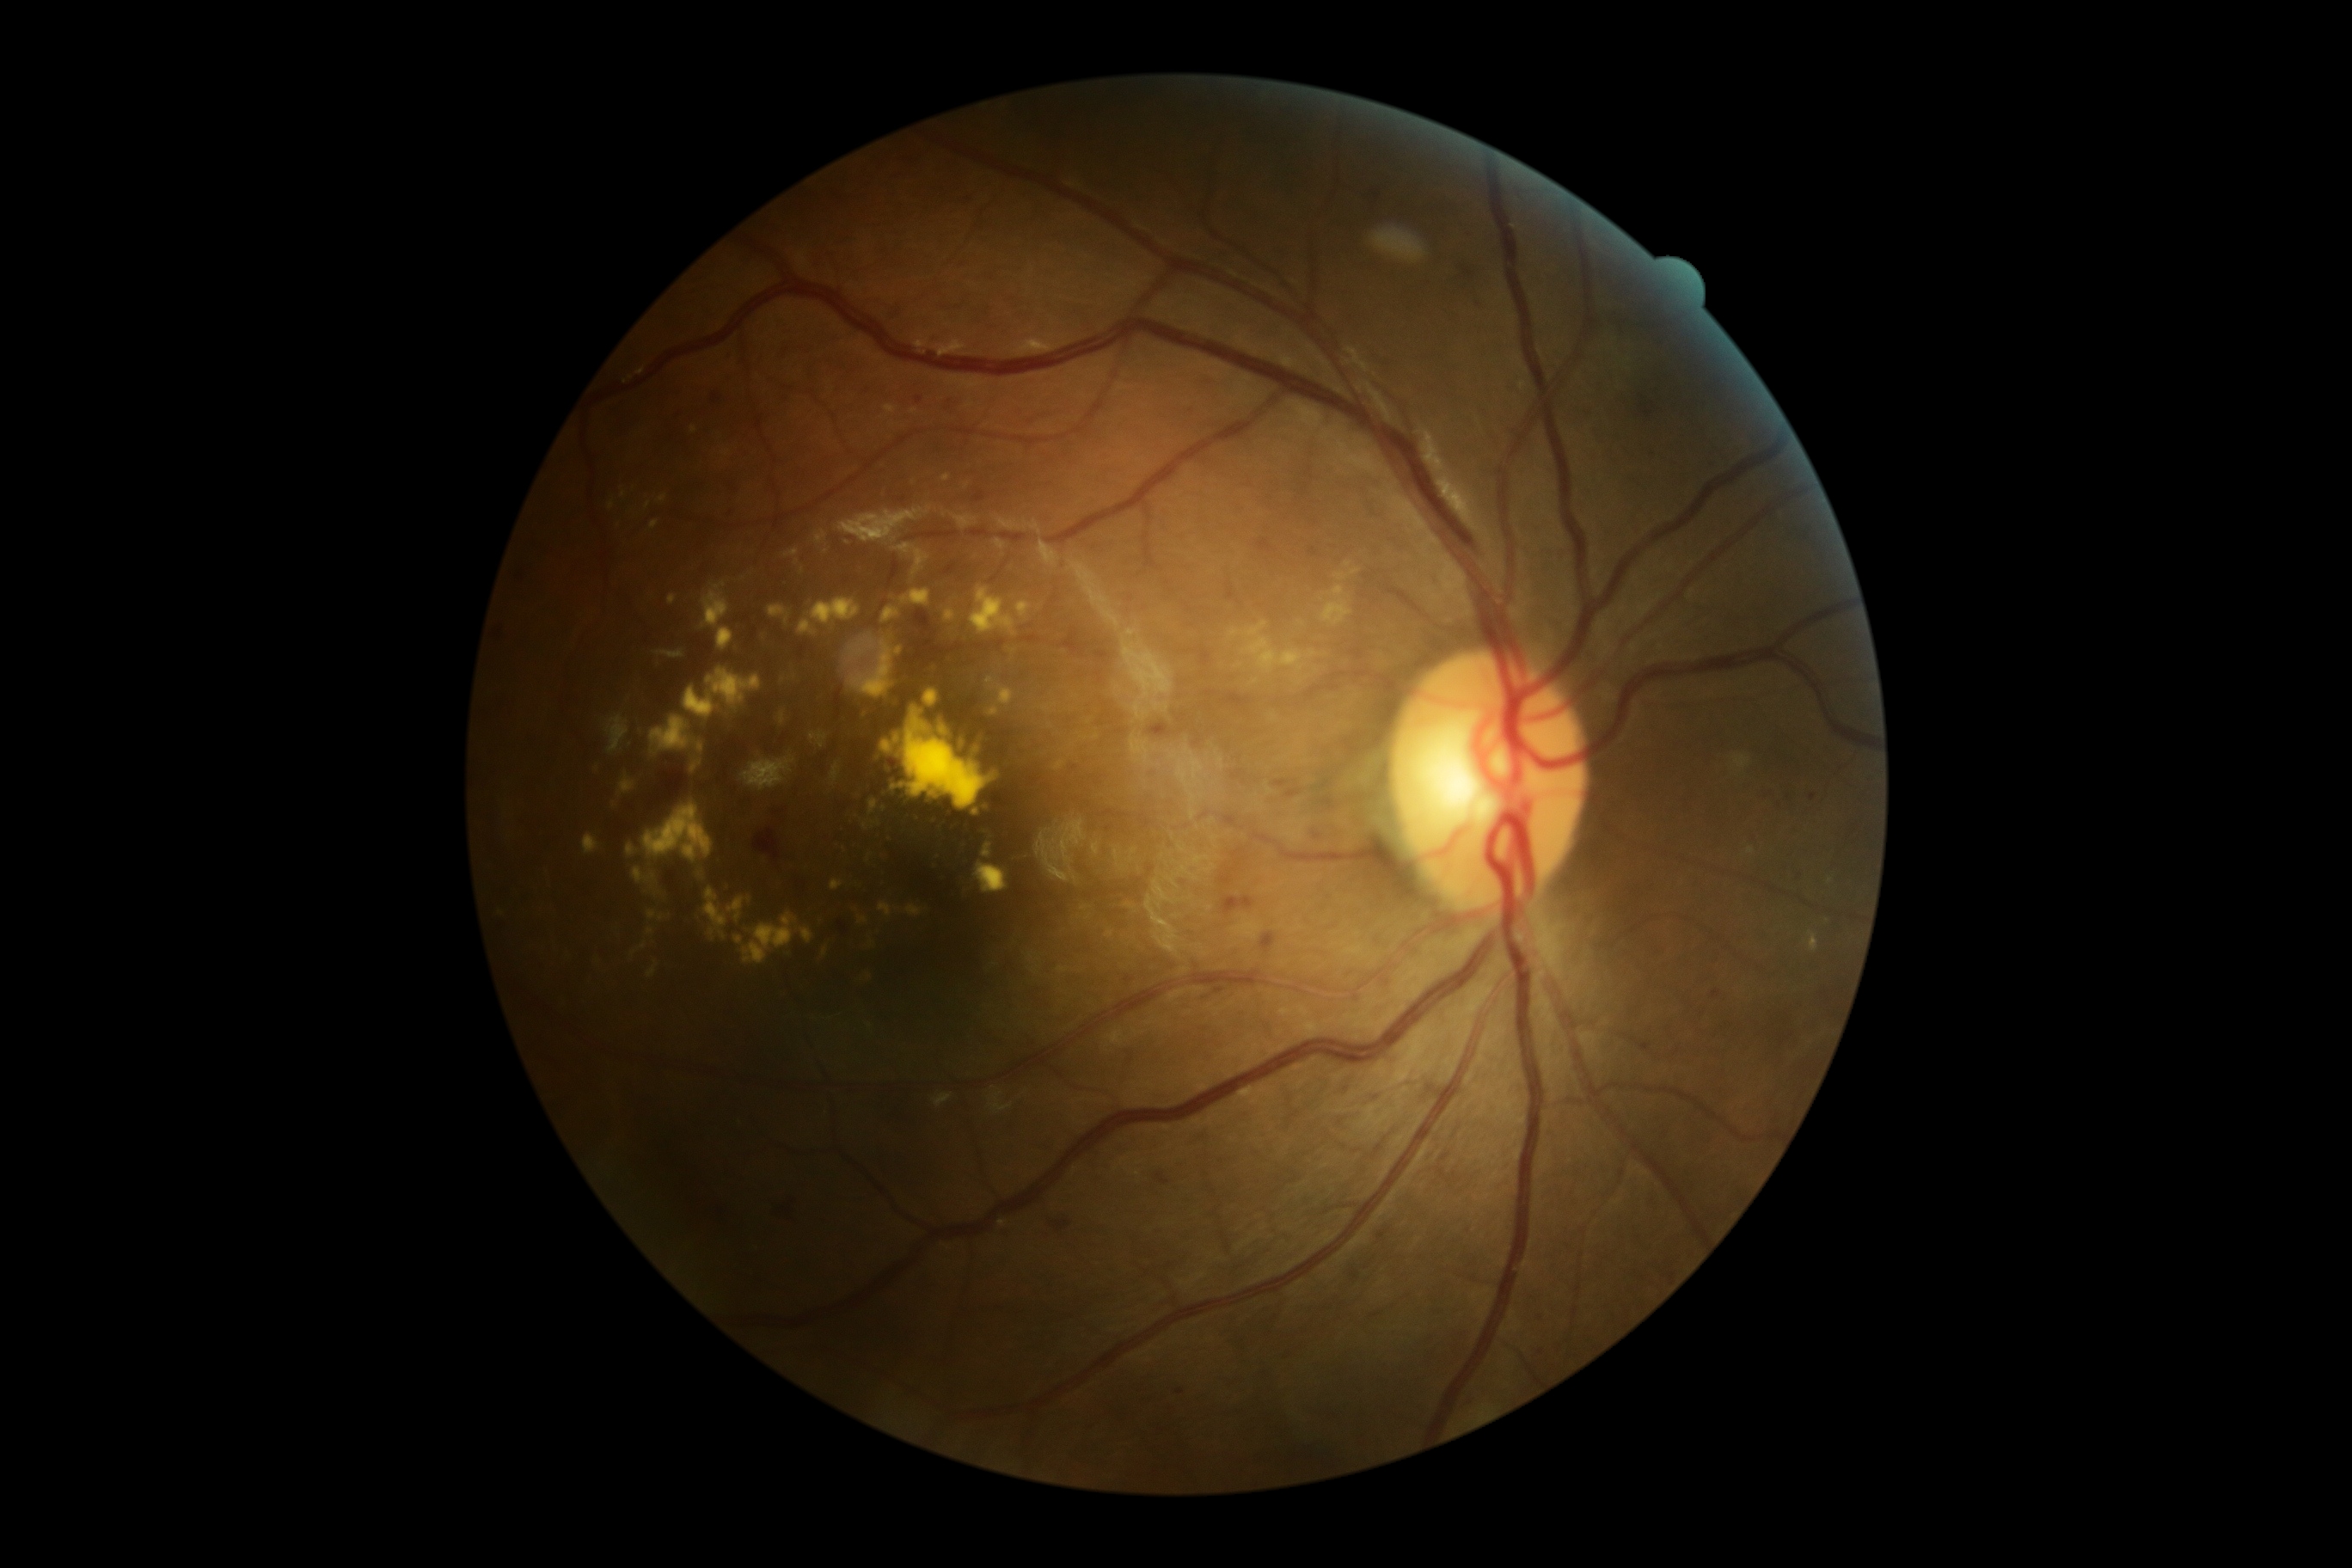
DR is moderate NPDR (grade 2) — more than just microaneurysms but less than severe NPDR; non-proliferative diabetic retinopathy
Representative lesions:
- EXs (subset): 697/744/704/754; 692/763/701/773; 871/821/881/826; 634/869/656/885; 976/740/983/756; 885/405/898/415; 647/912/666/922; 878/902/893/919; 883/606/900/623; 895/647/902/656; 651/716/692/752; 768/604/790/623; 683/668/761/720; 831/879/843/891; 974/862/1008/895; 646/501/651/510
- Small EXs approximately at <point>915, 573</point>; <point>897, 909</point>; <point>614, 806</point>; <point>992, 775</point>